Pediatric wide-field fundus photograph · Clarity RetCam 3, 130° FOV — 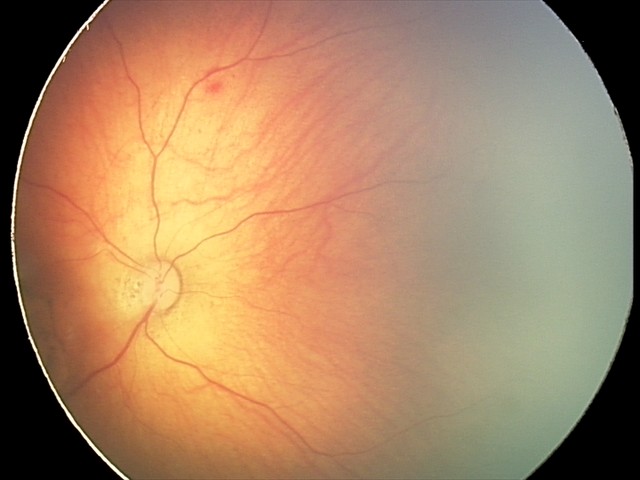

Series diagnosed as toxoplasmosis chorioretinitis.